Acquired with a NIDEK AFC-230 · 45 degree fundus photograph
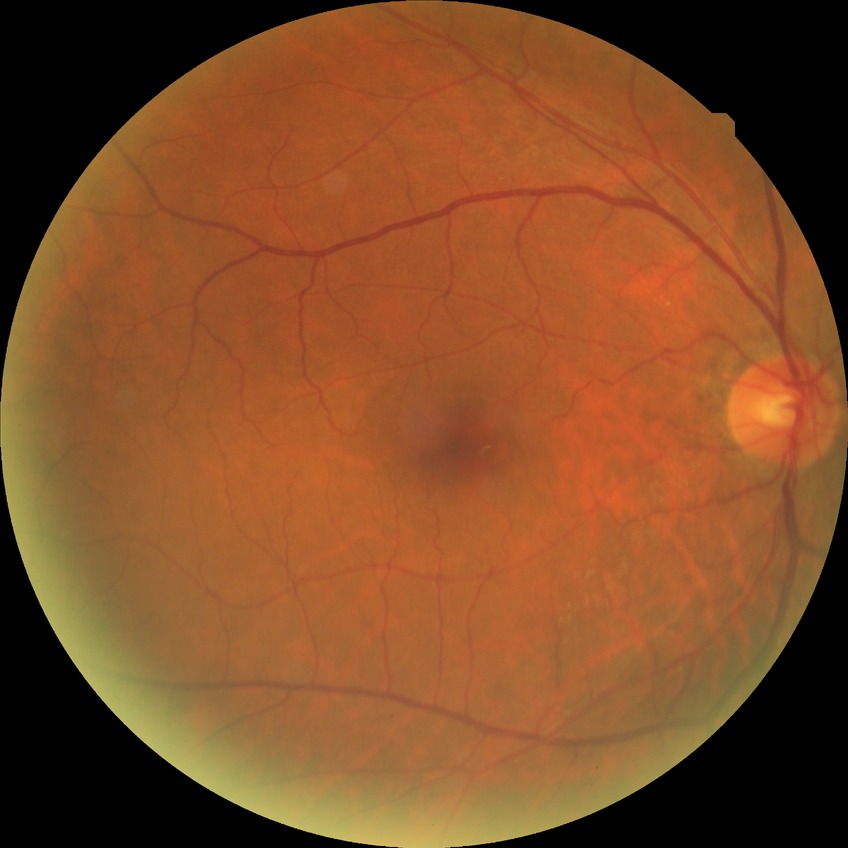

{"davis_grade": "NDR (no diabetic retinopathy)"}